FOV: 45 degrees. CFP.
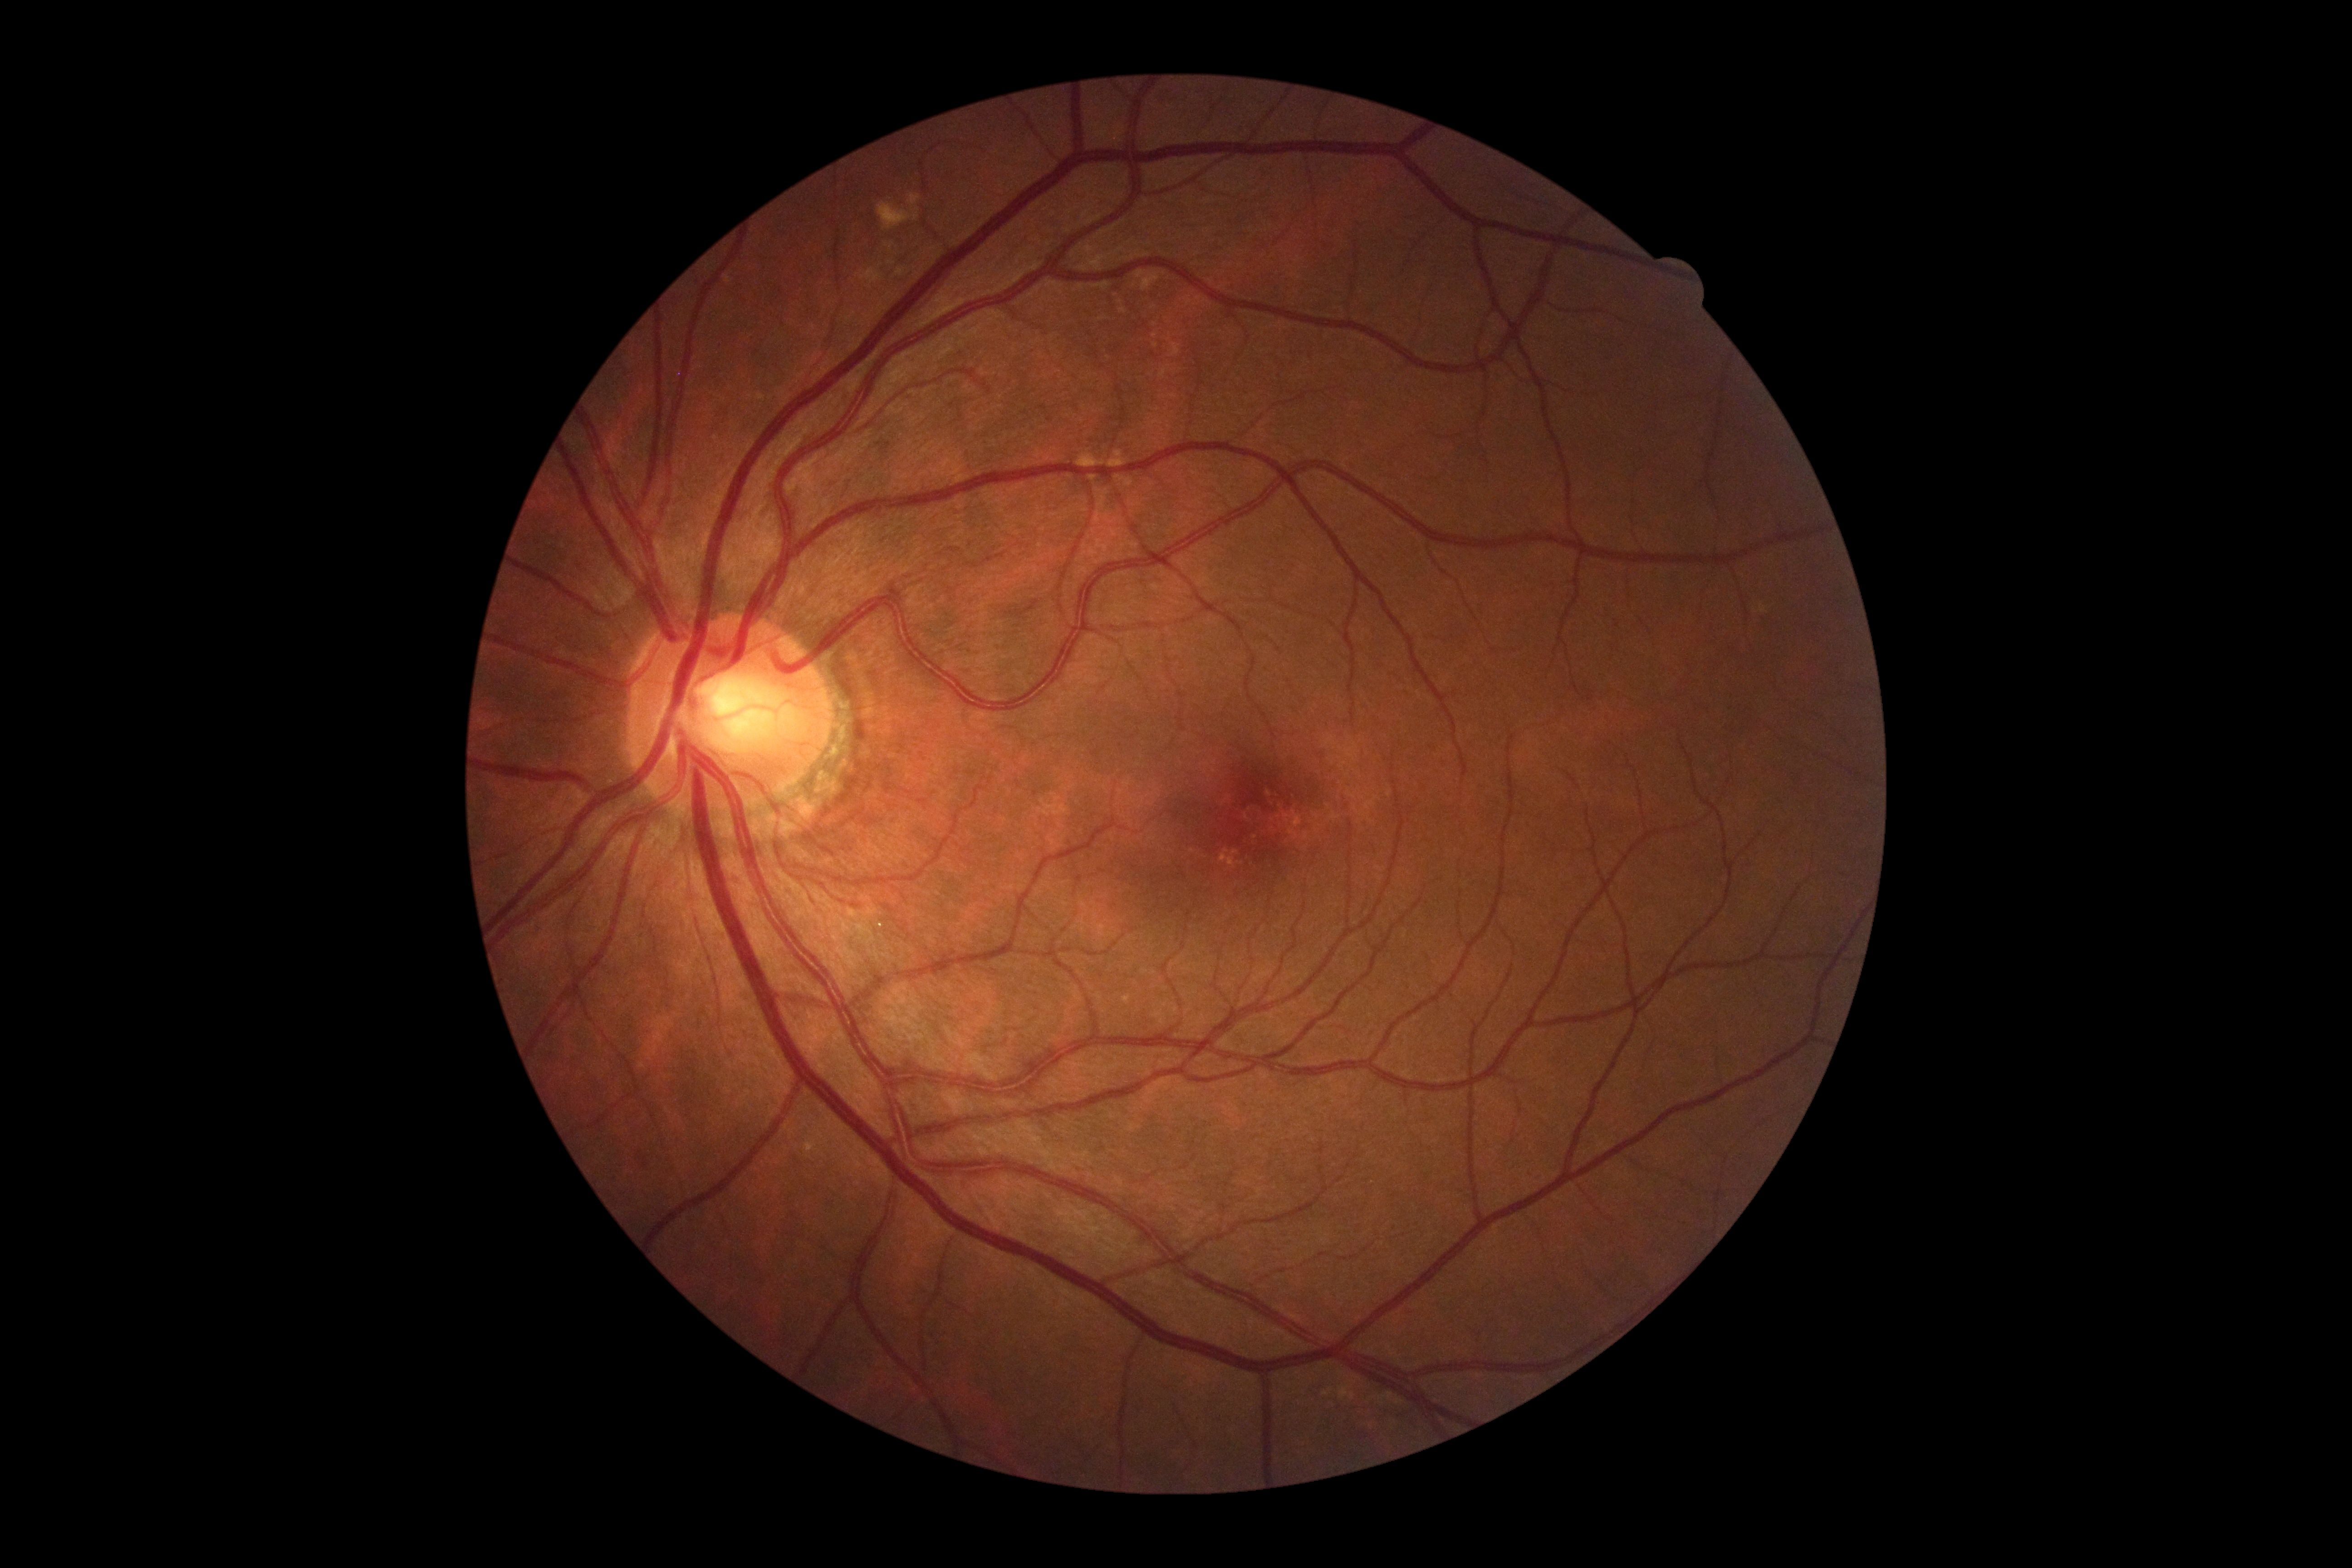 DR grade is 0 — no visible signs of diabetic retinopathy.